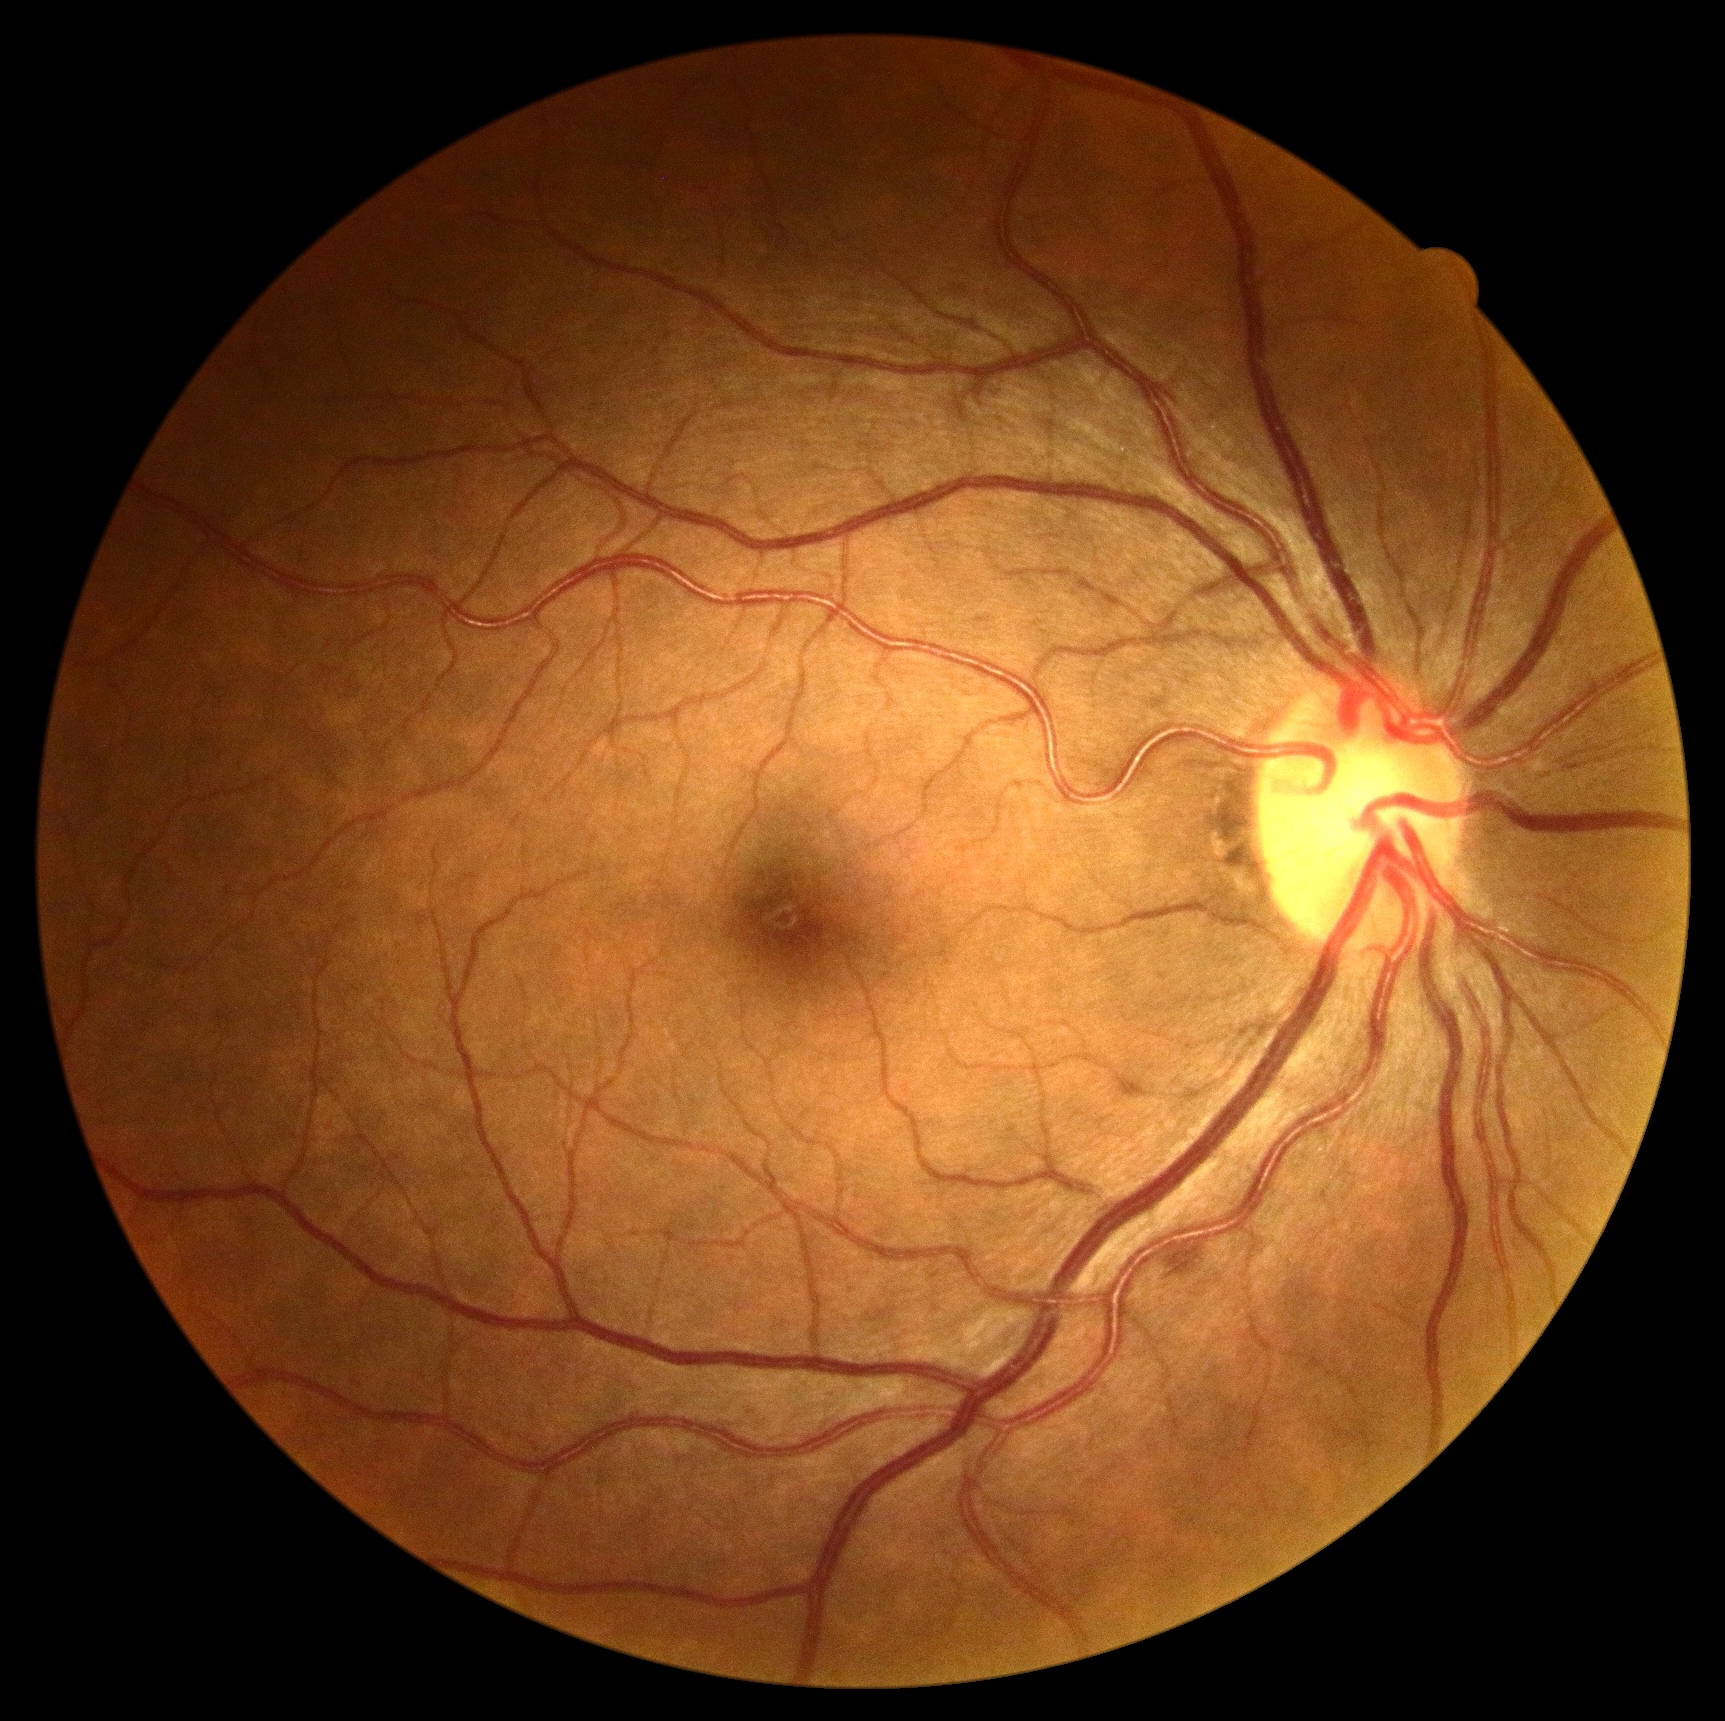 Retinopathy grade: 2 (moderate NPDR) — more than just microaneurysms but less than severe NPDR.